Wide-field fundus image from infant ROP screening
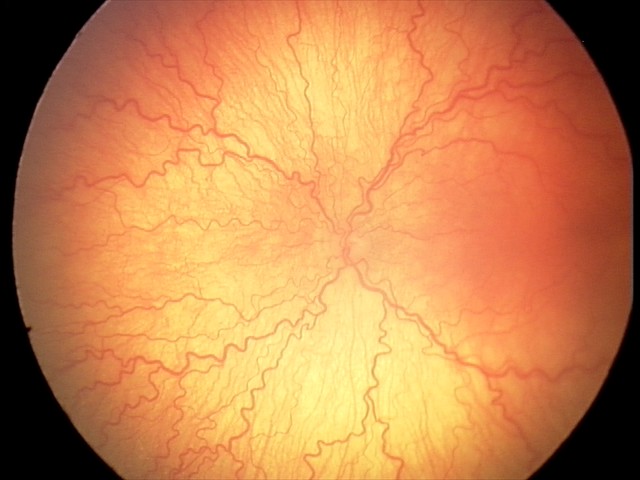
Examination diagnosed as aggressive retinopathy of prematurity.